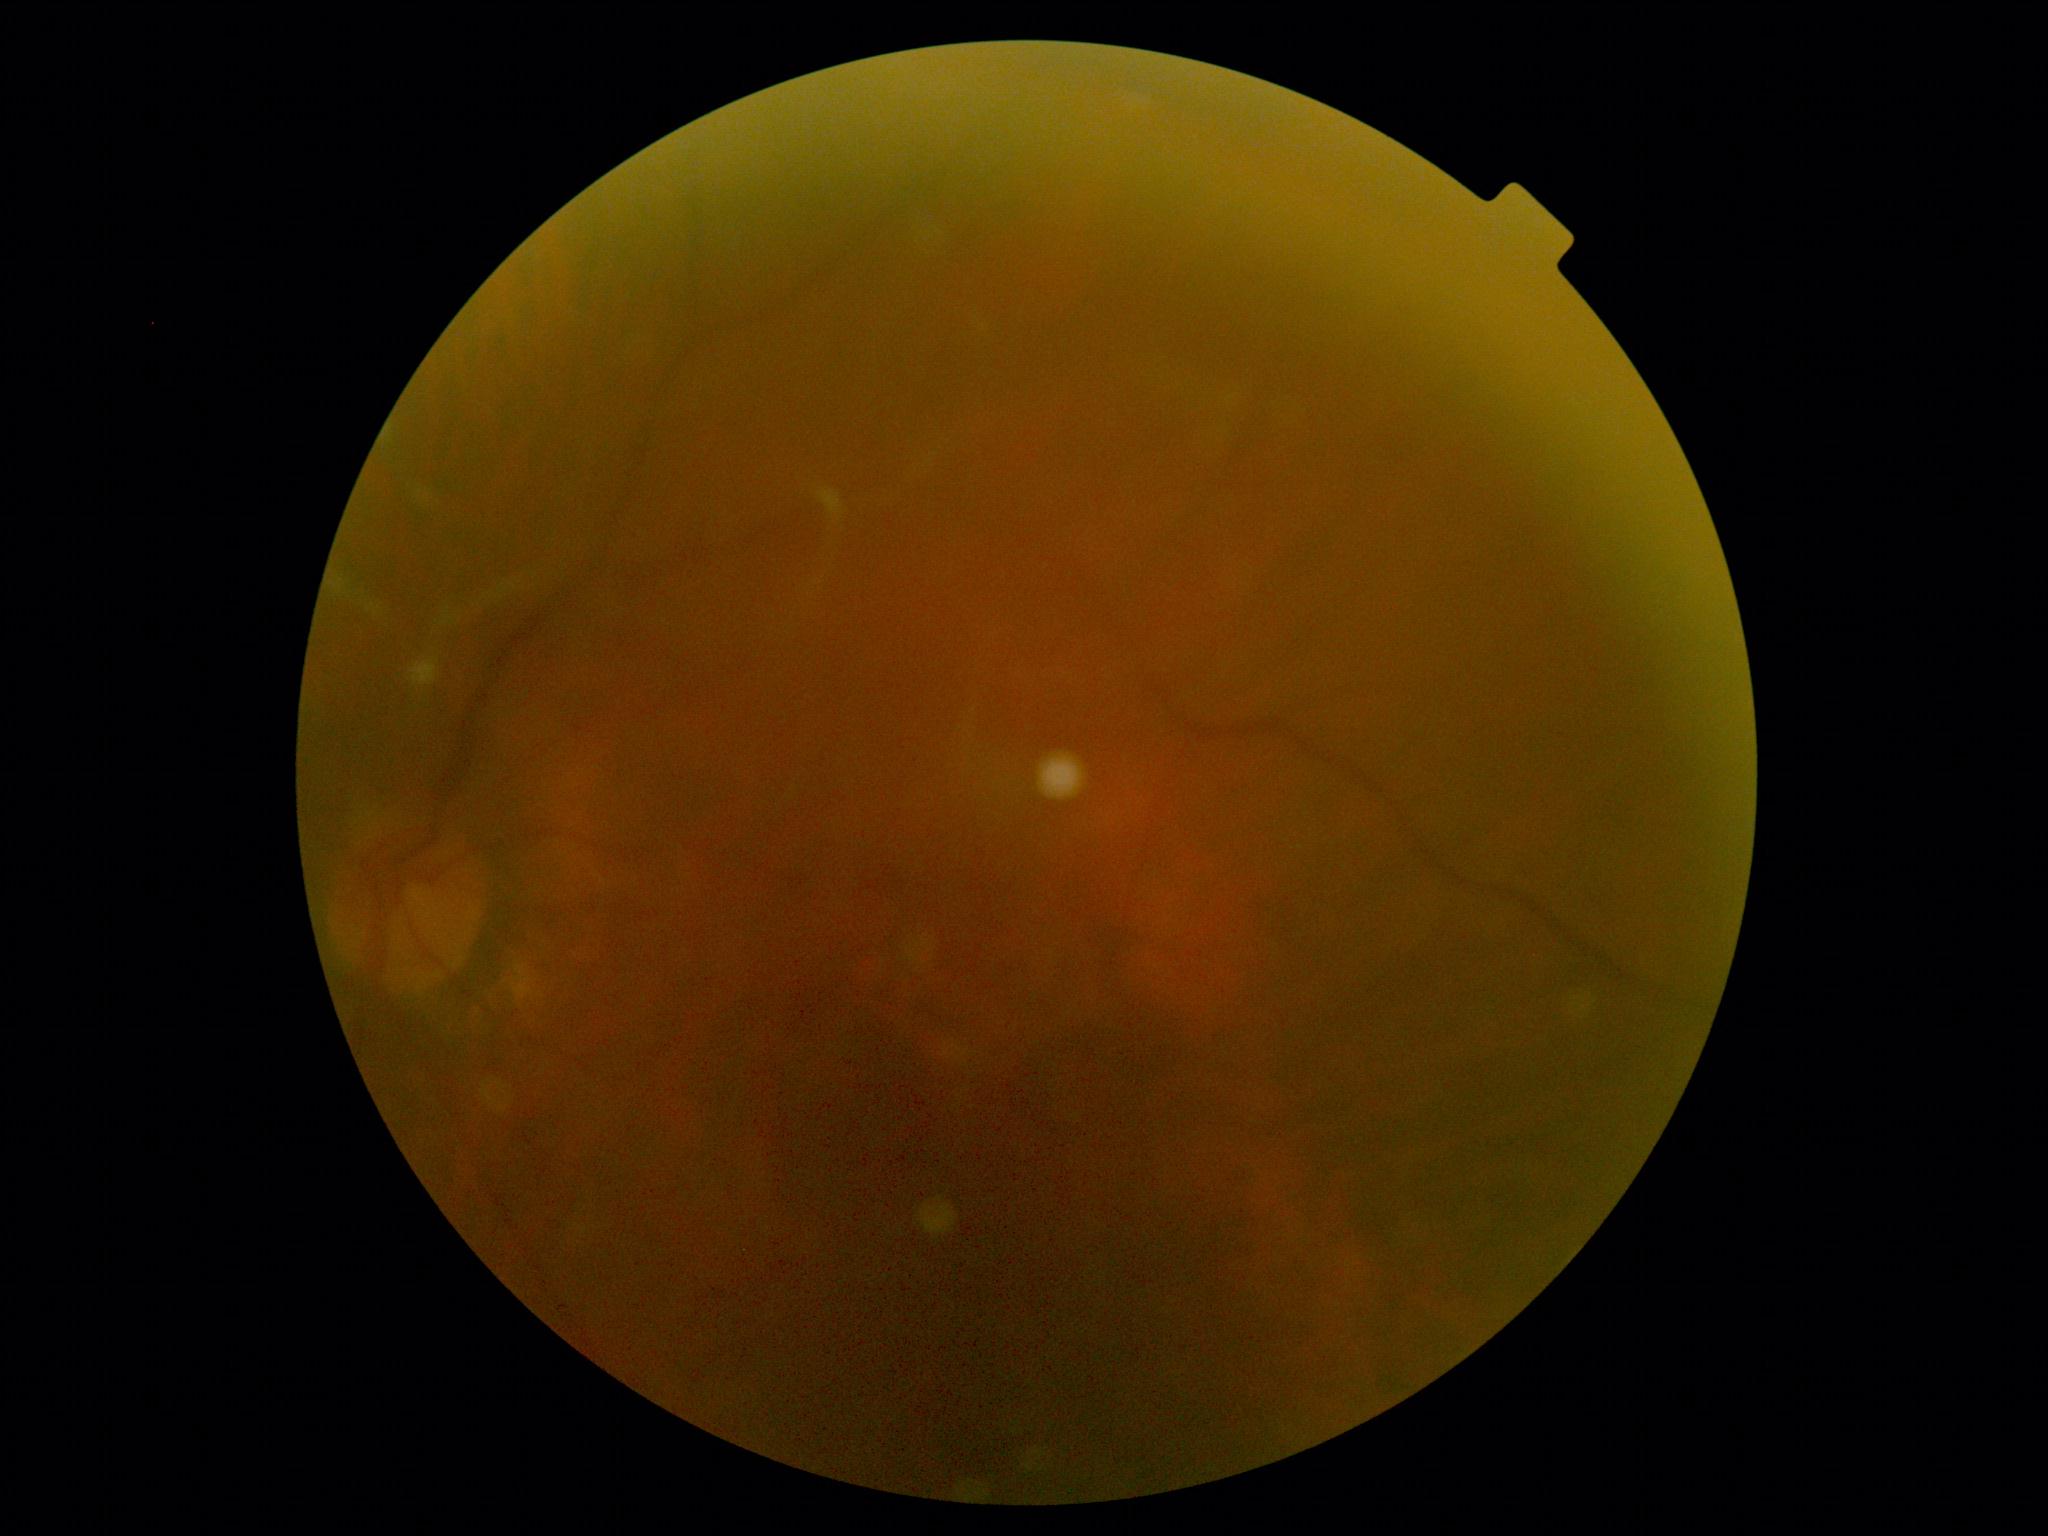
No signs of diabetic retinopathy.
Diabetic retinopathy is 0.